45-degree field of view; retinal fundus photograph.
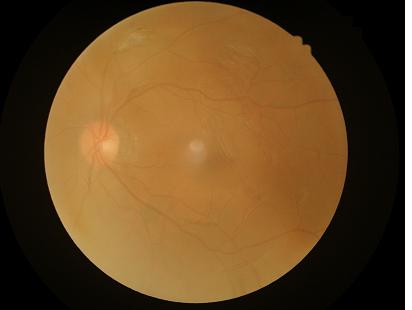
Reduced sharpness with visible blur. Overall quality is poor; the image is difficult to grade. Narrow intensity range; structures are hard to distinguish.